Non-mydriatic fundus camera: 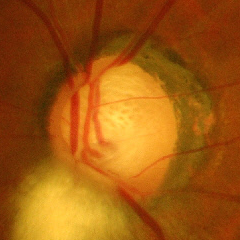
Q: Does this eye have glaucoma?
A: Severe glaucomatous damage.